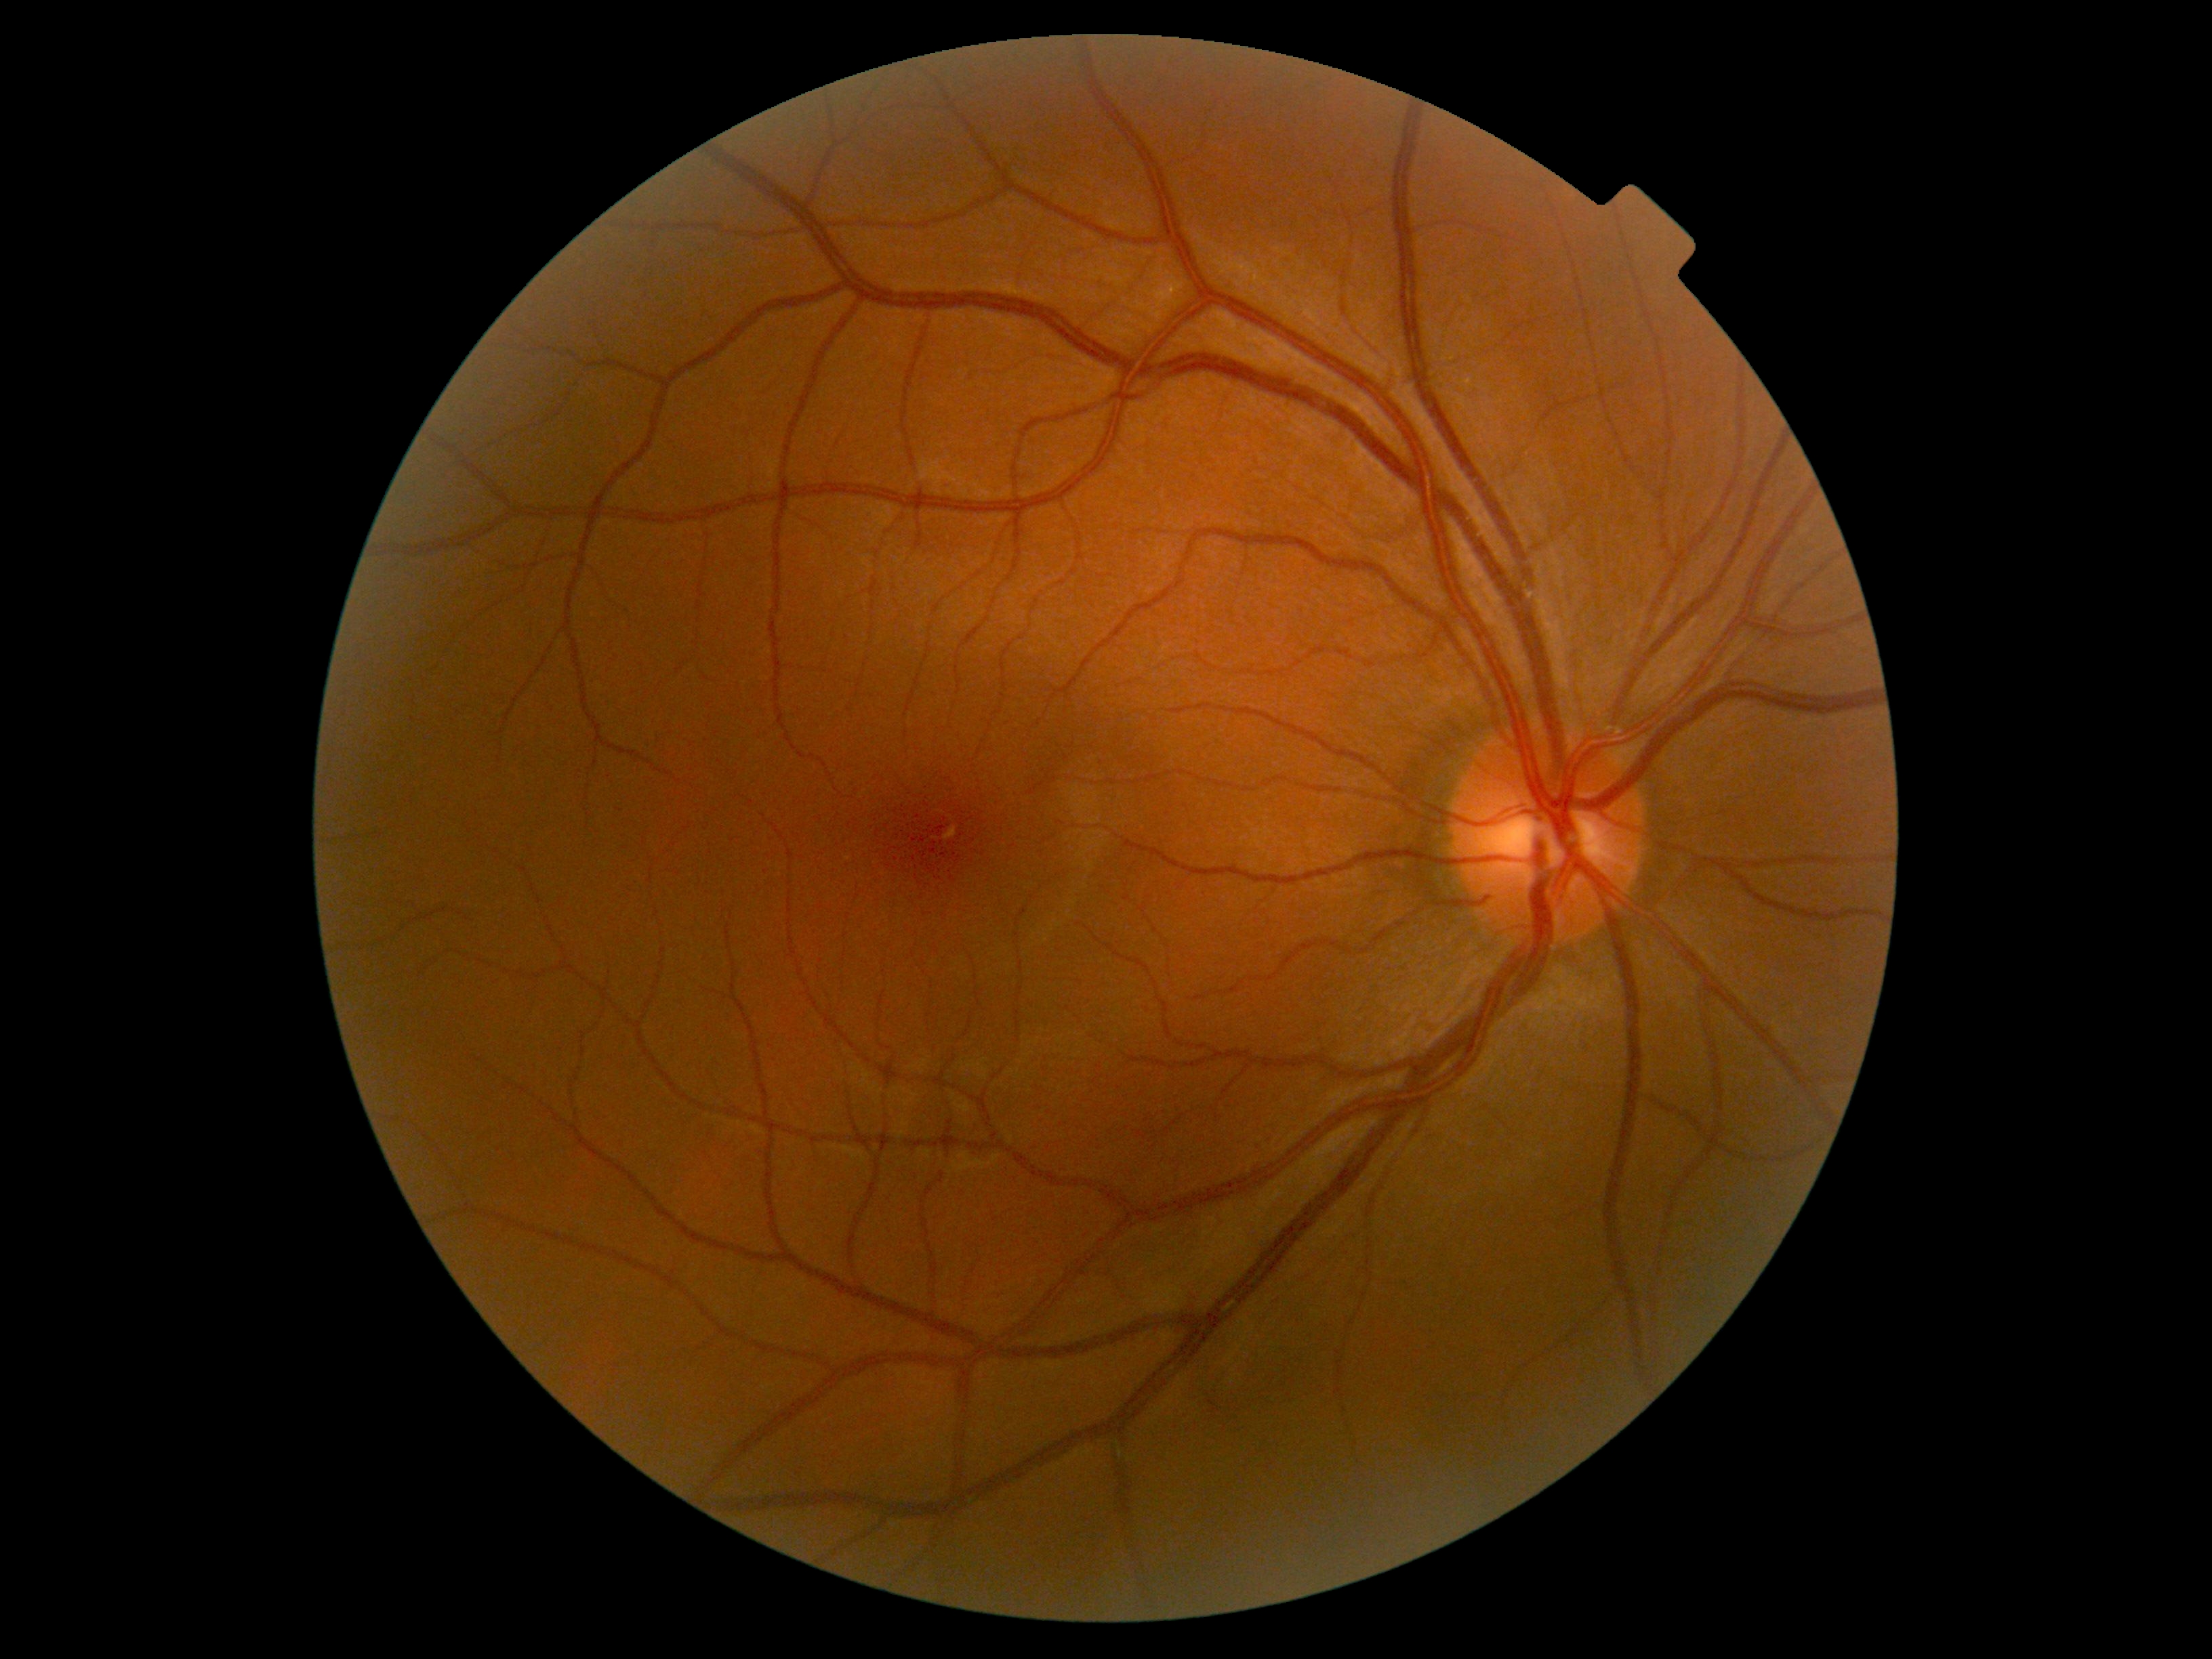

diabetic retinopathy (DR): grade 0 — no visible signs of diabetic retinopathy.